1240 x 1240 pixels; Phoenix ICON wide-field infant fundus image:
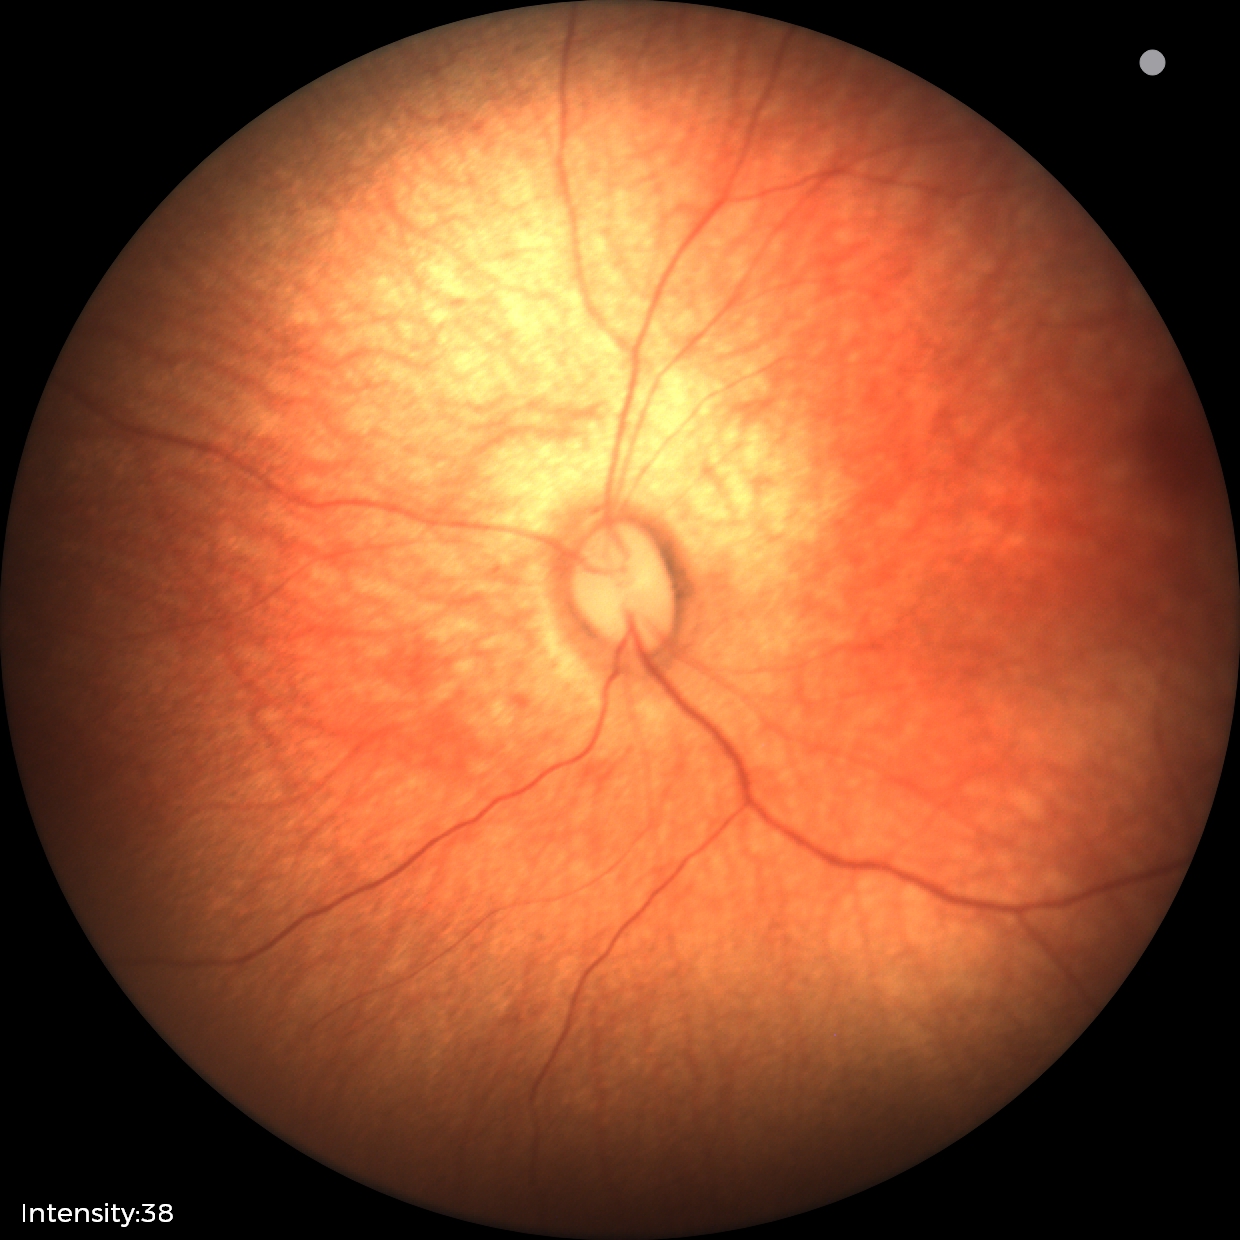

Screening examination diagnosed as physiological.